Wide-field fundus image from infant ROP screening: 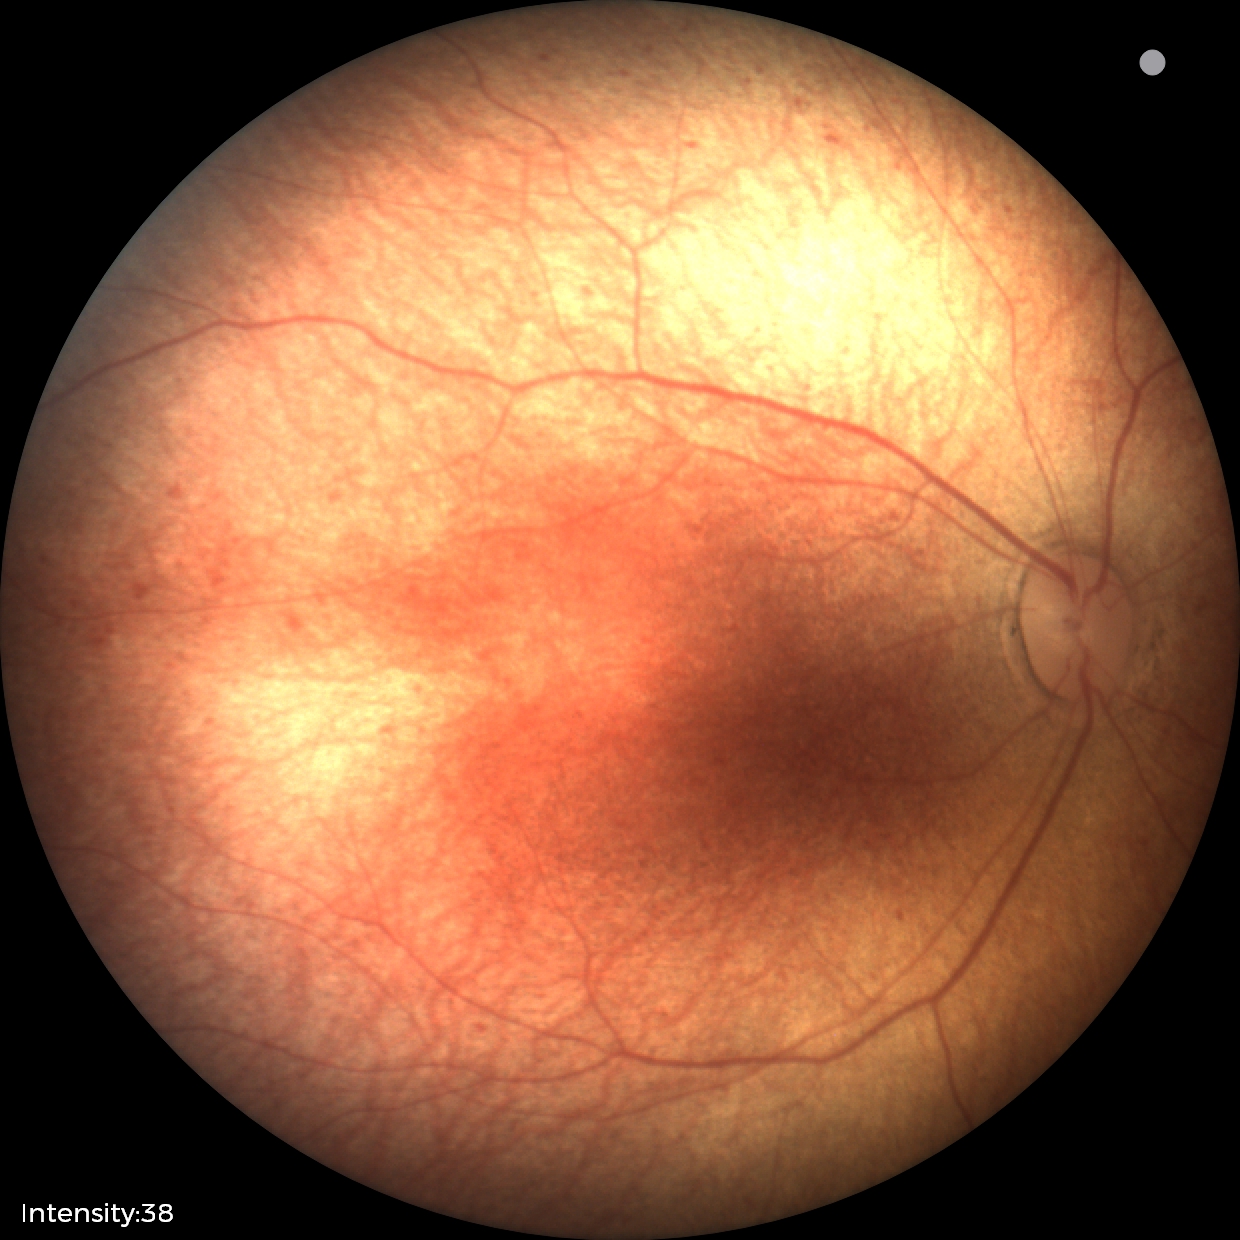
No retinal pathology identified on screening.